Pediatric retinal photograph (wide-field). Captured with the Natus RetCam Envision (130° field of view) — 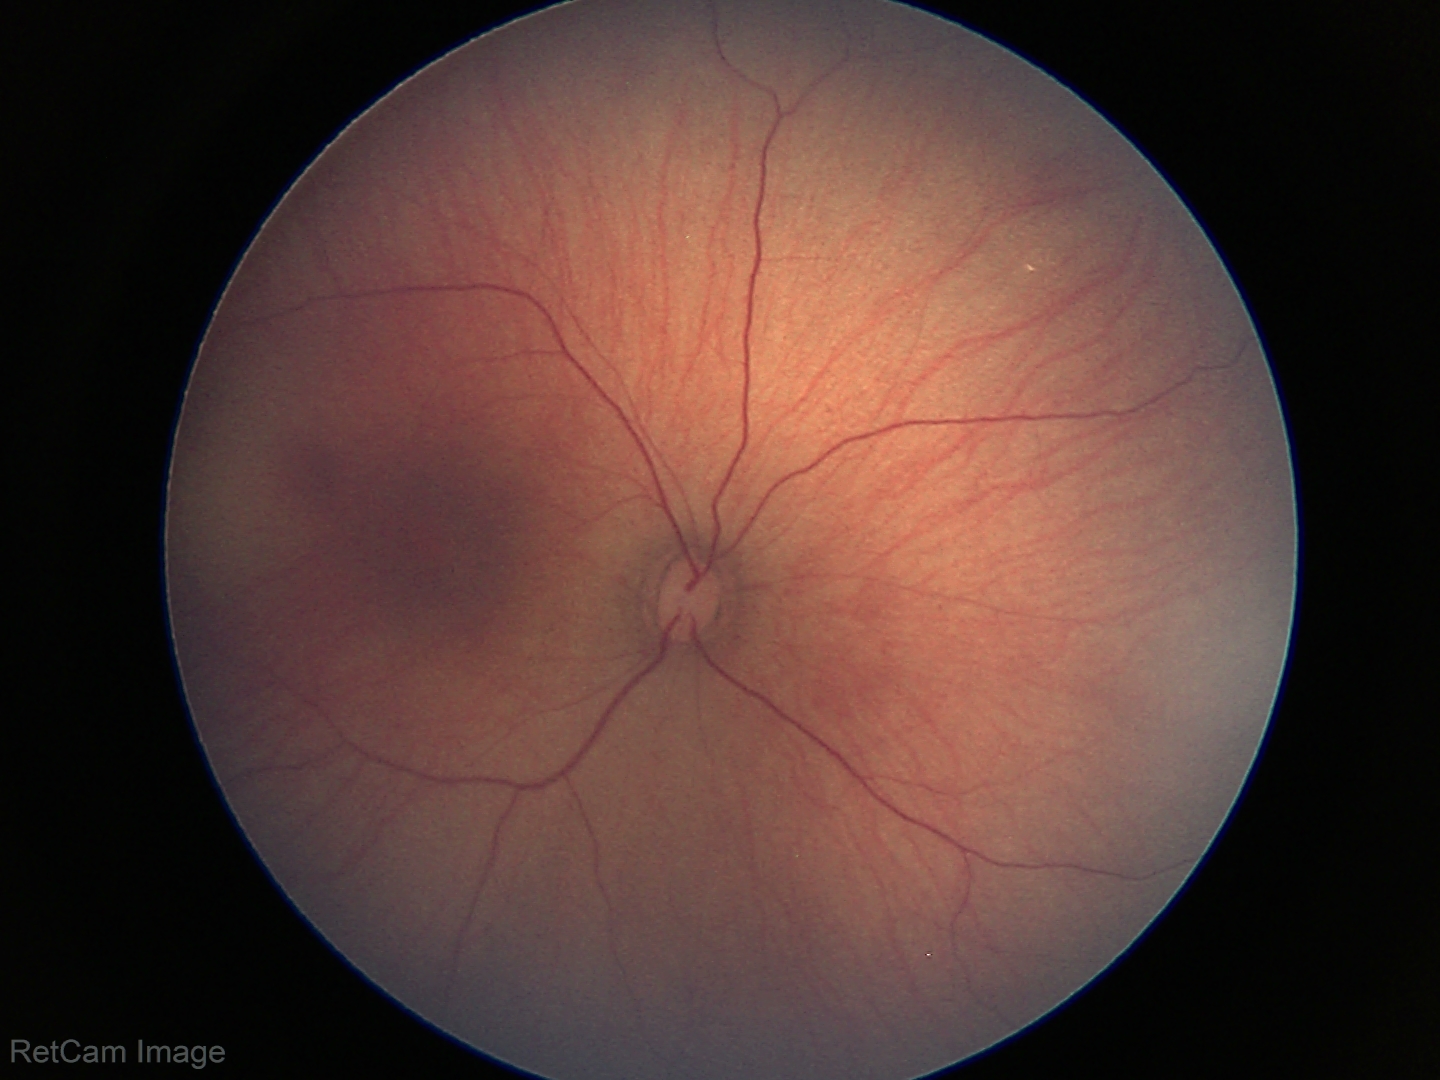 Examination with physiological retinal findings.